Wide-field contact fundus photograph of an infant · Phoenix ICON, 100° FOV: 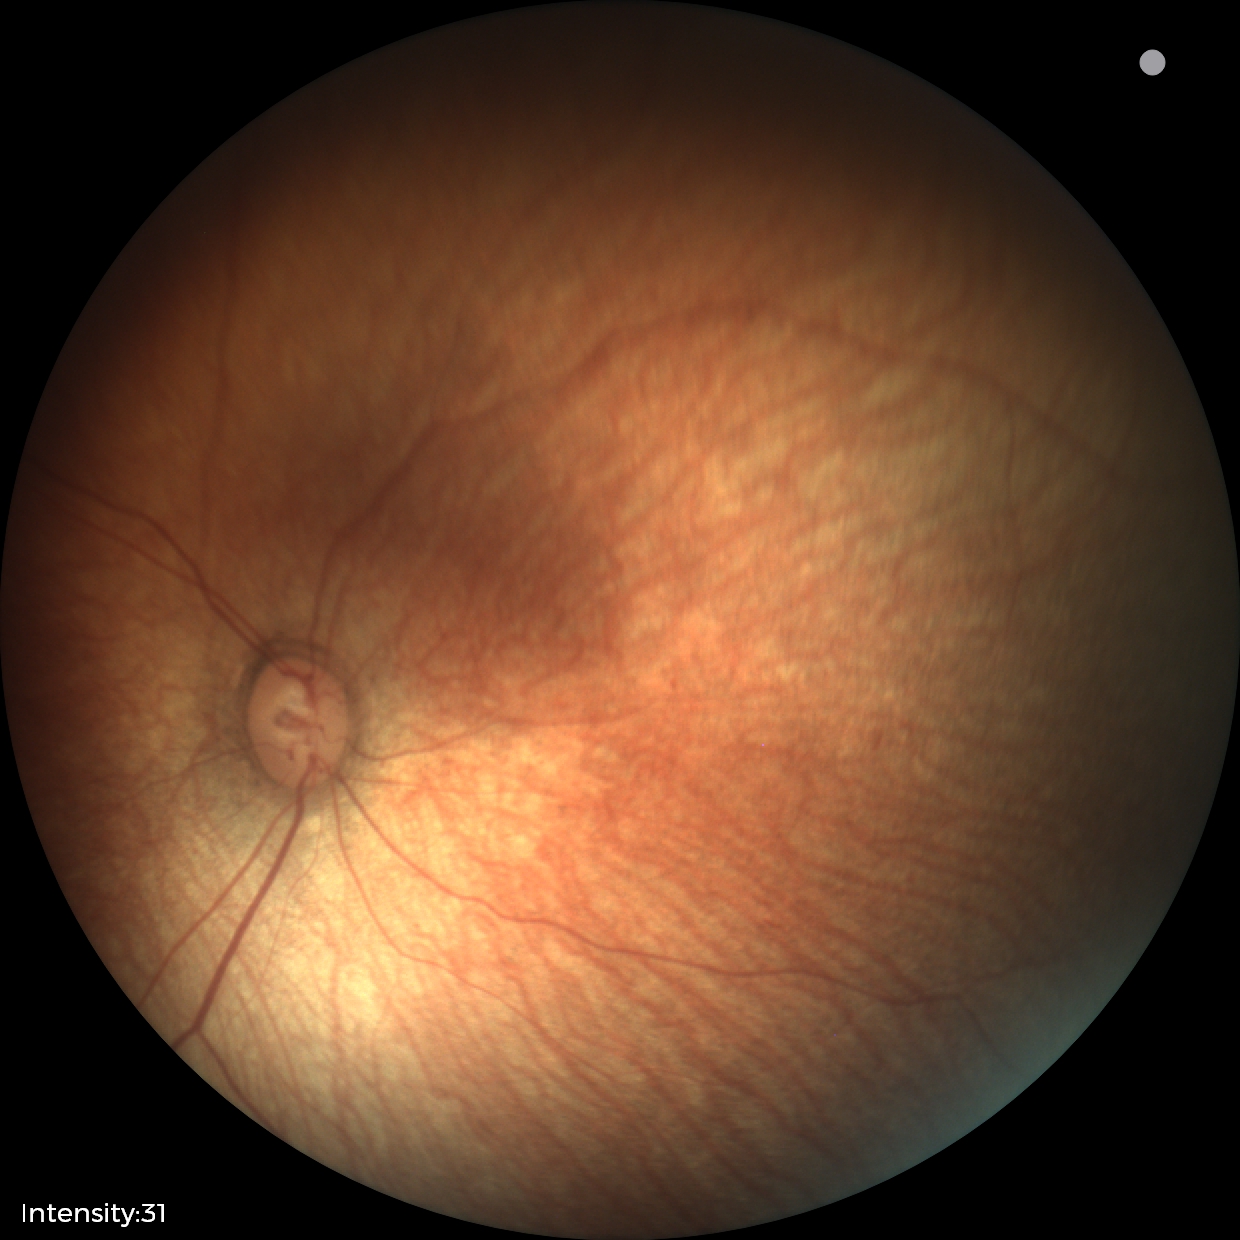 Screening examination with no abnormal retinal findings.